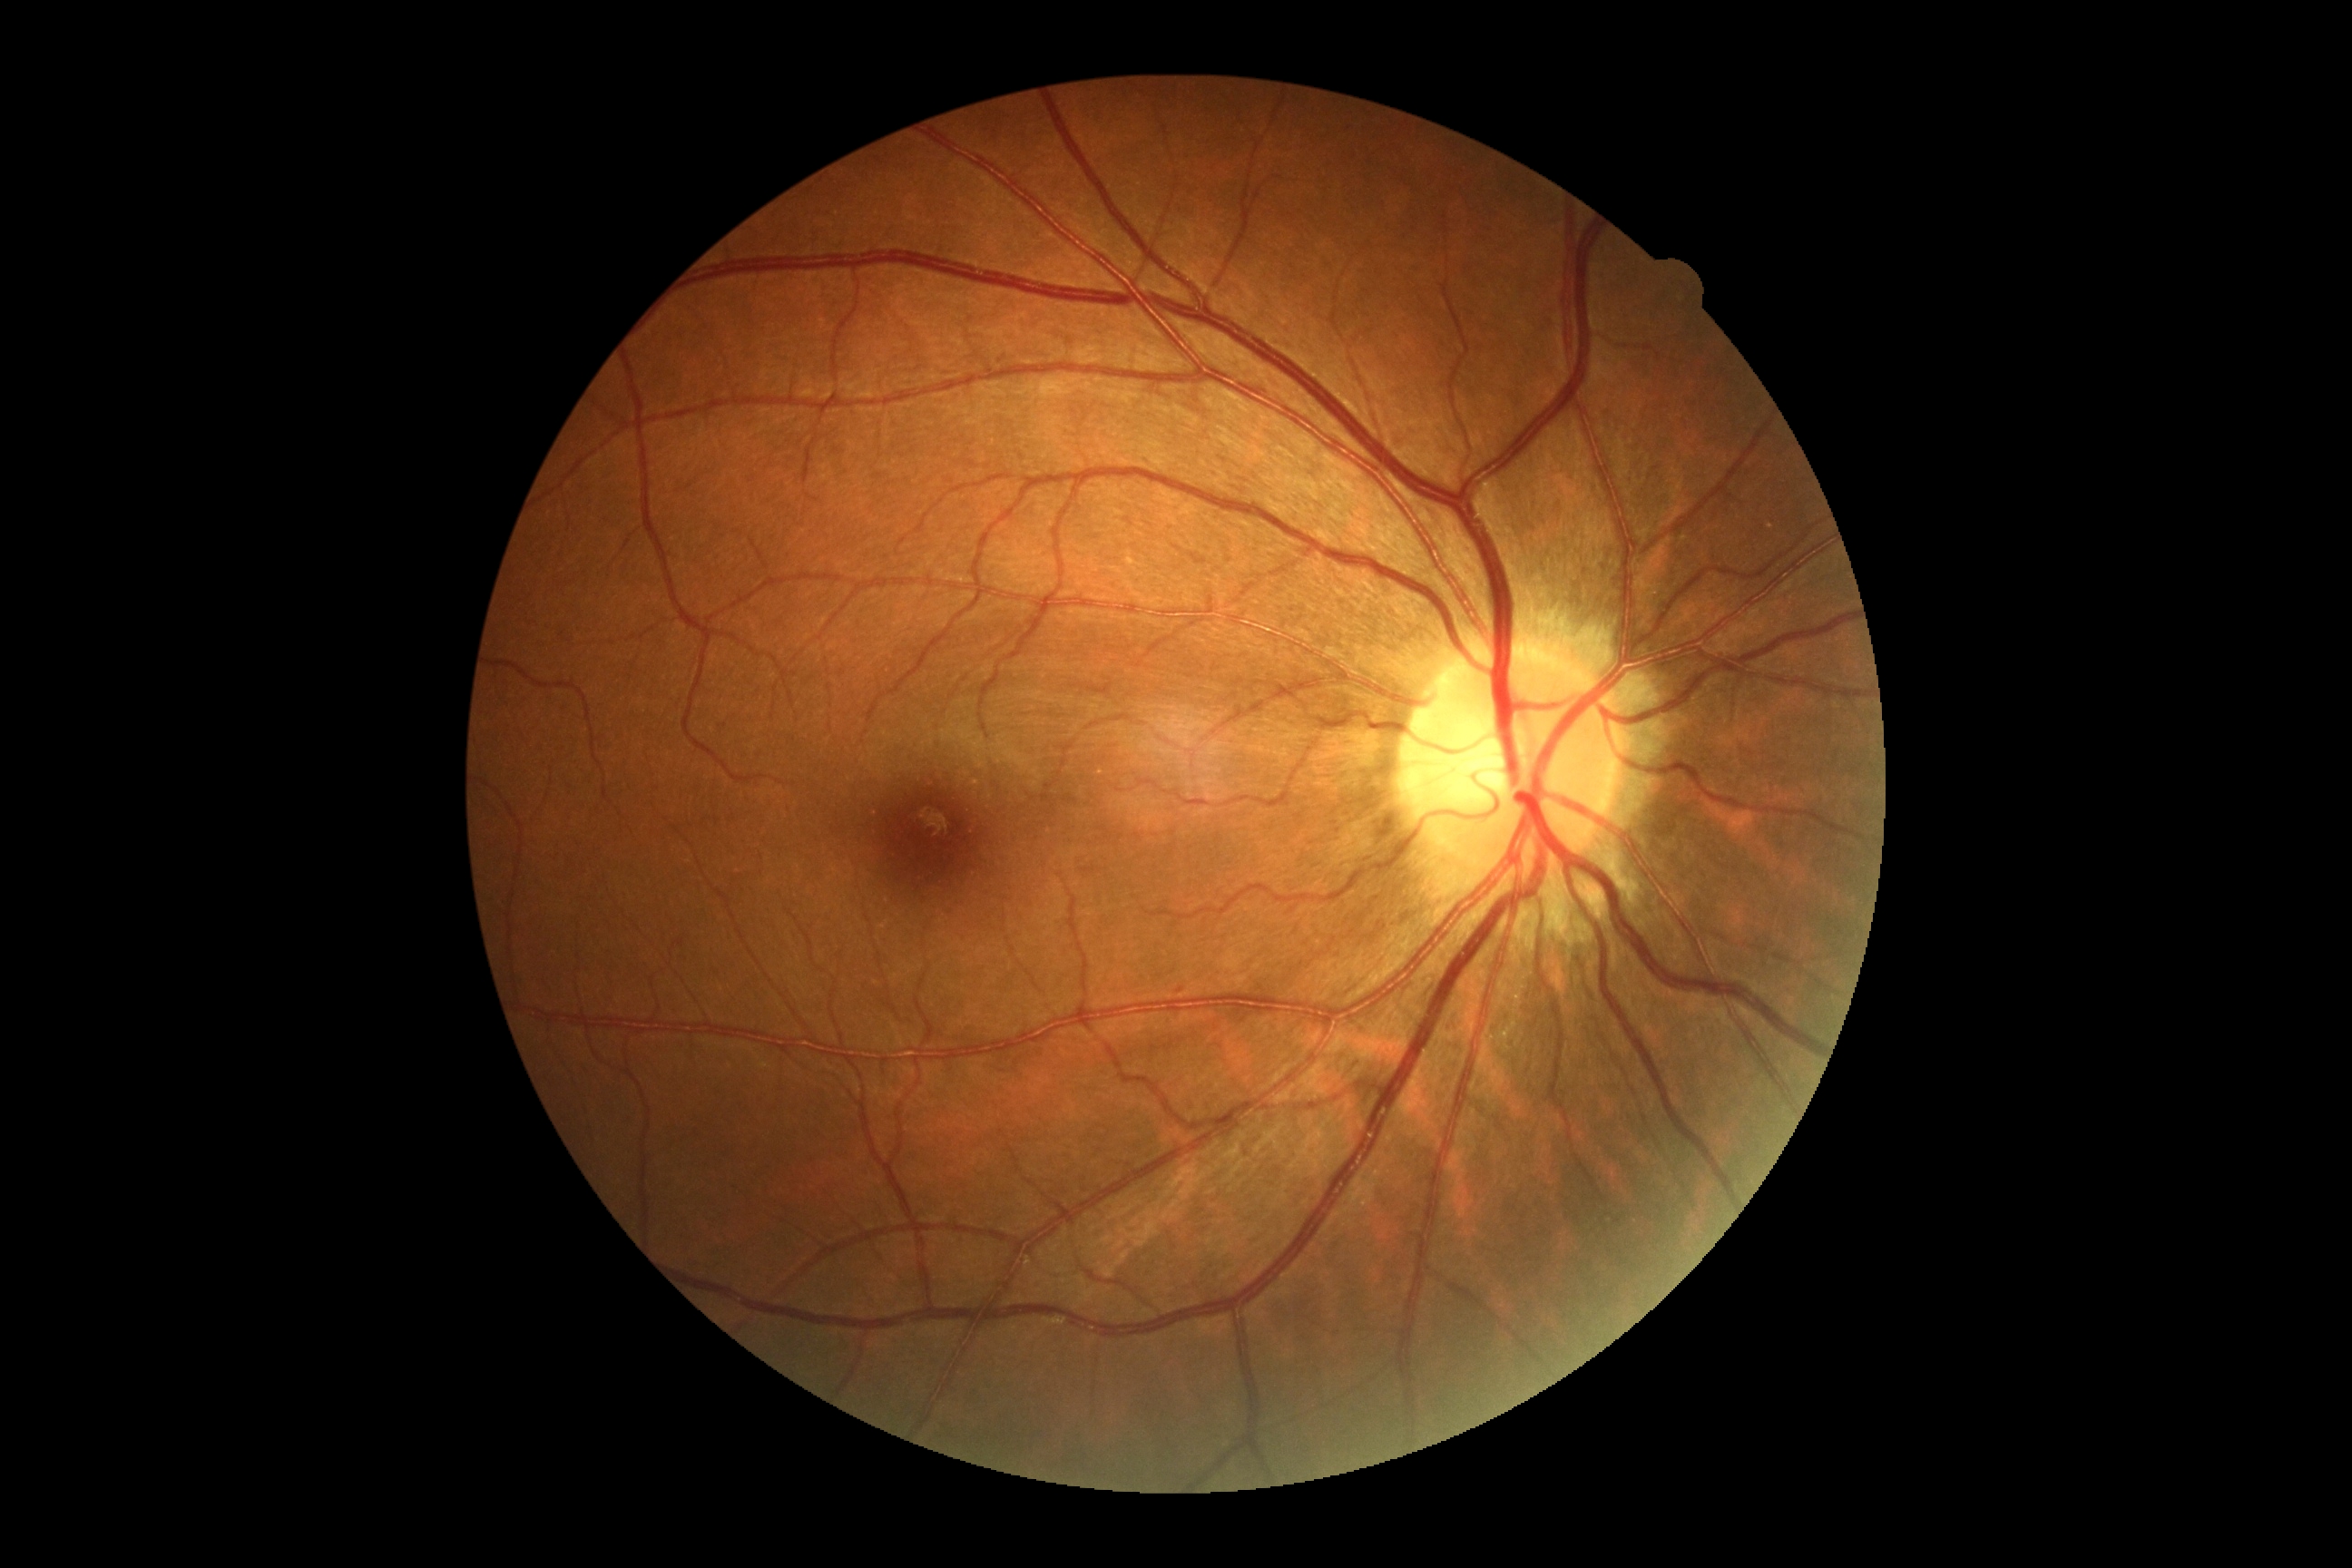
DR: no apparent retinopathy (grade 0).